Retinal fundus photograph. 45° FOV. 2352 by 1568 pixels:
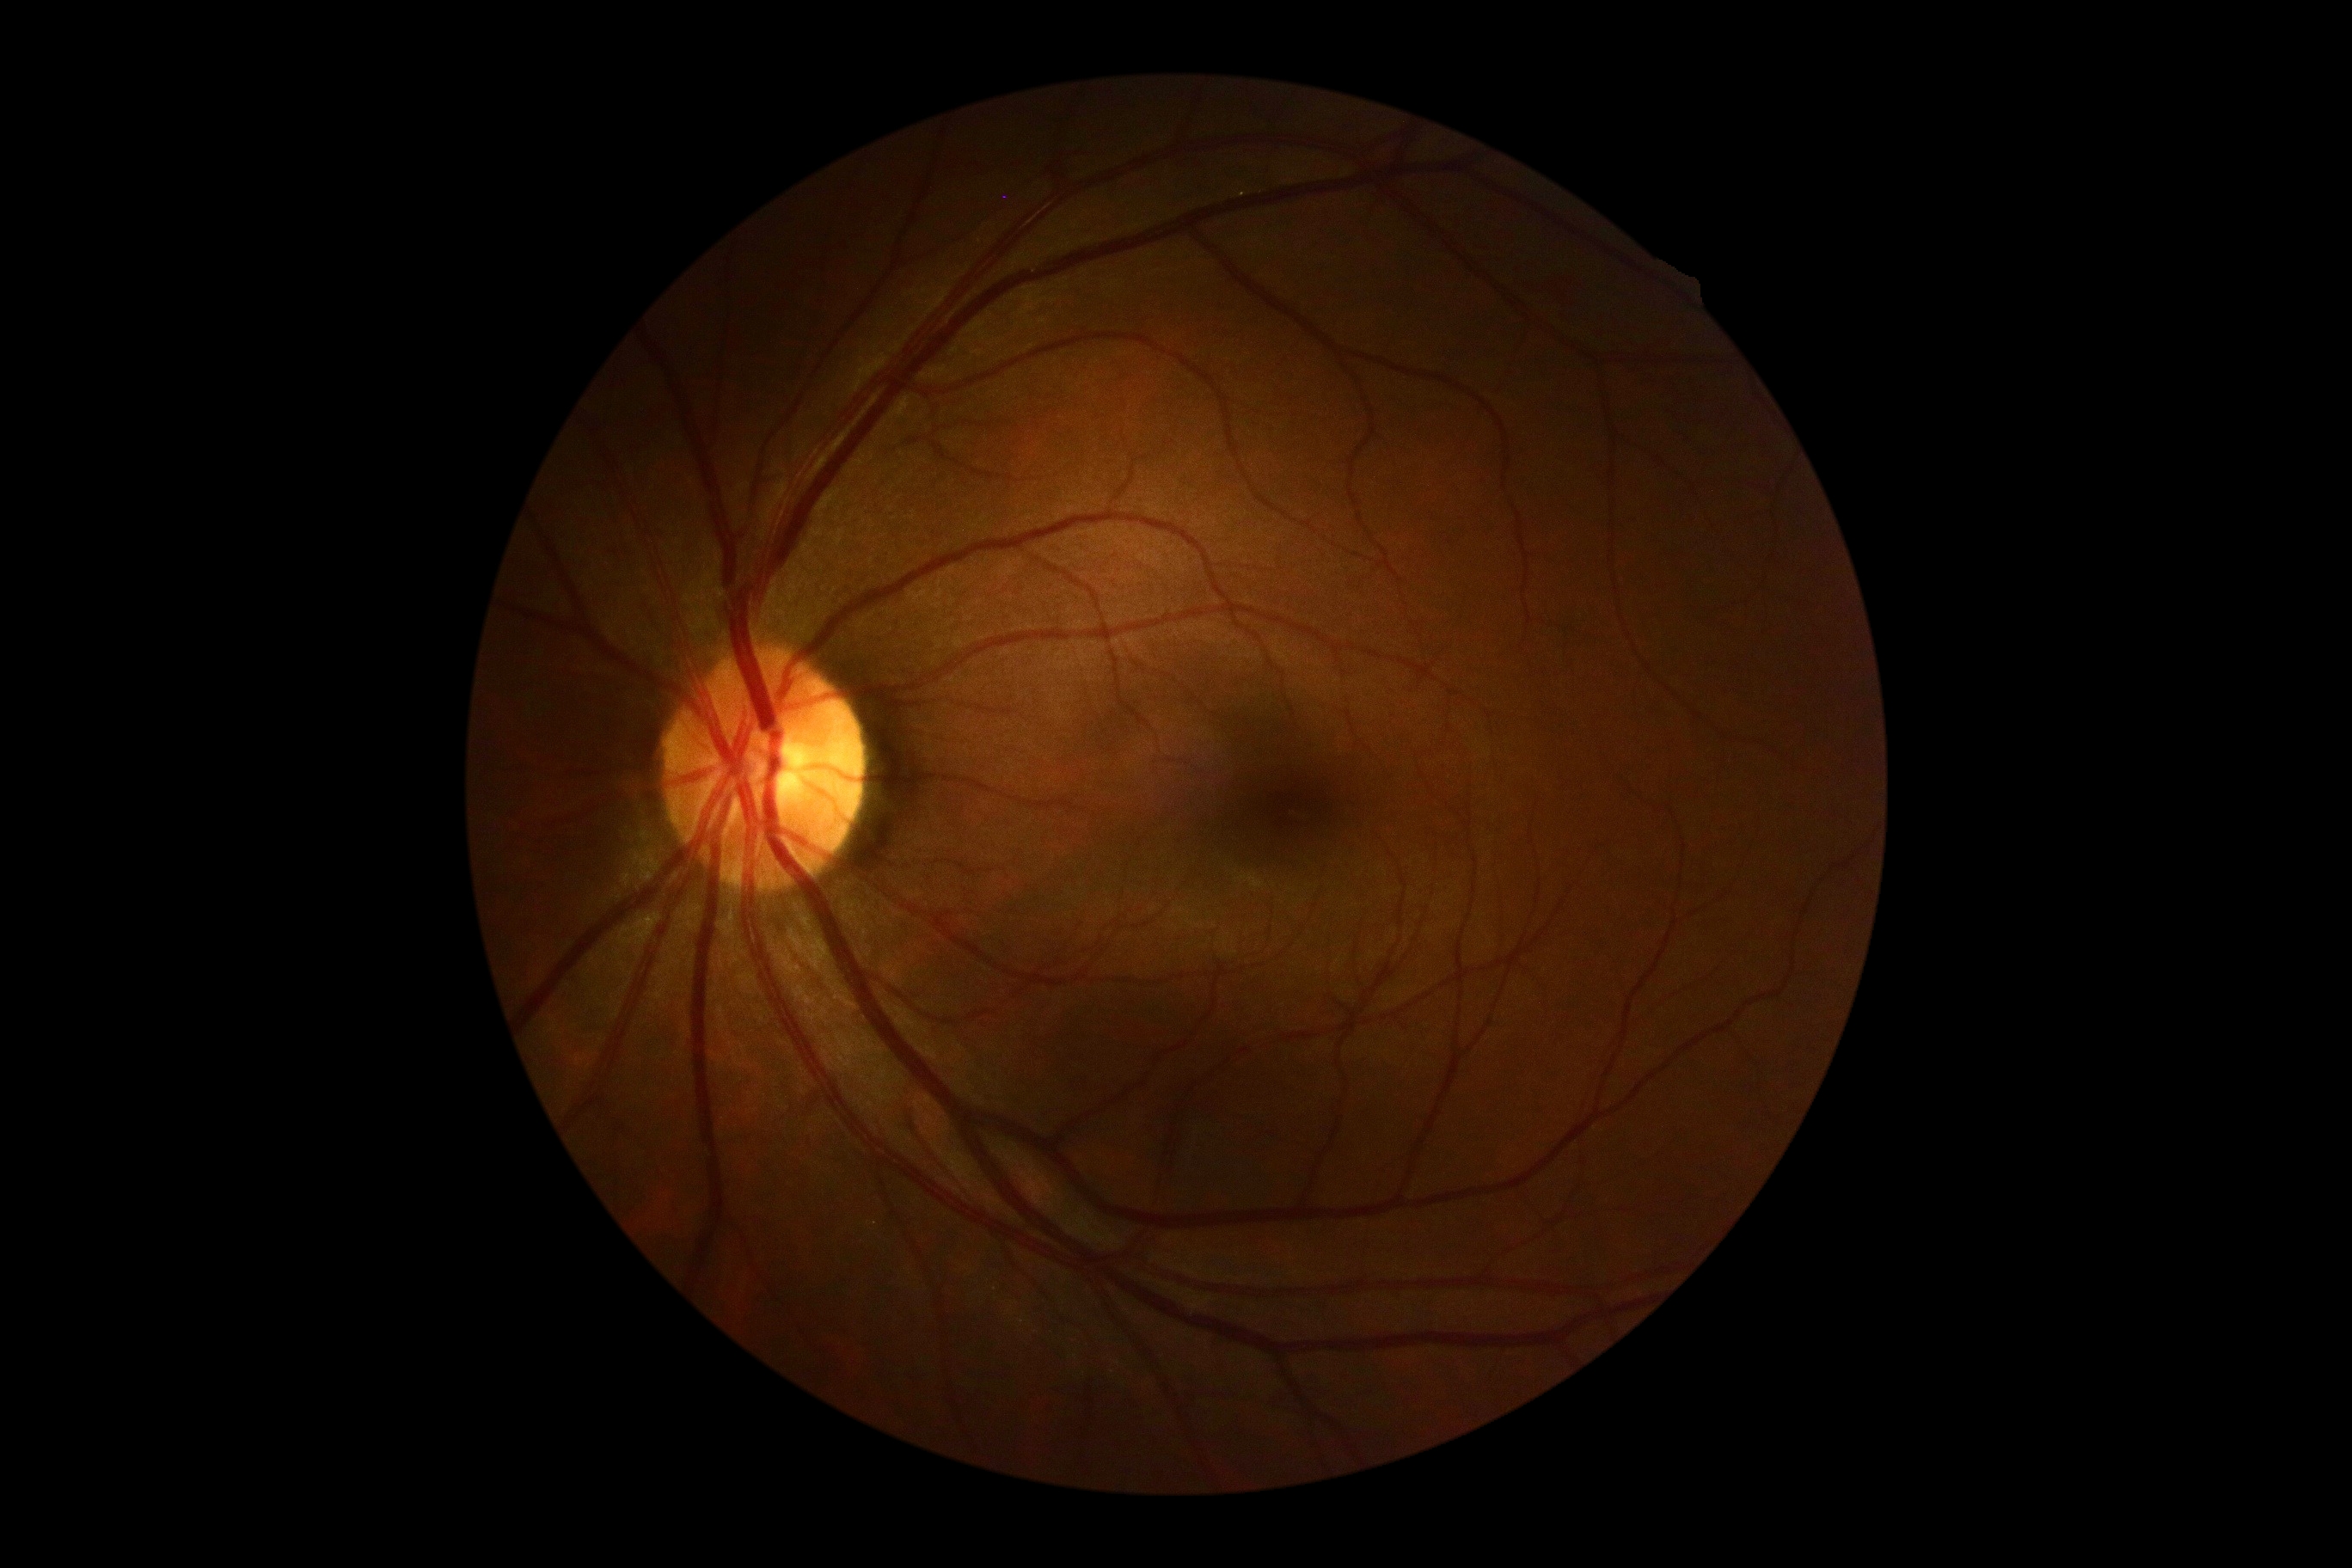

Findings:
– DR impression — no apparent DR
– diabetic retinopathy (DR) — 0